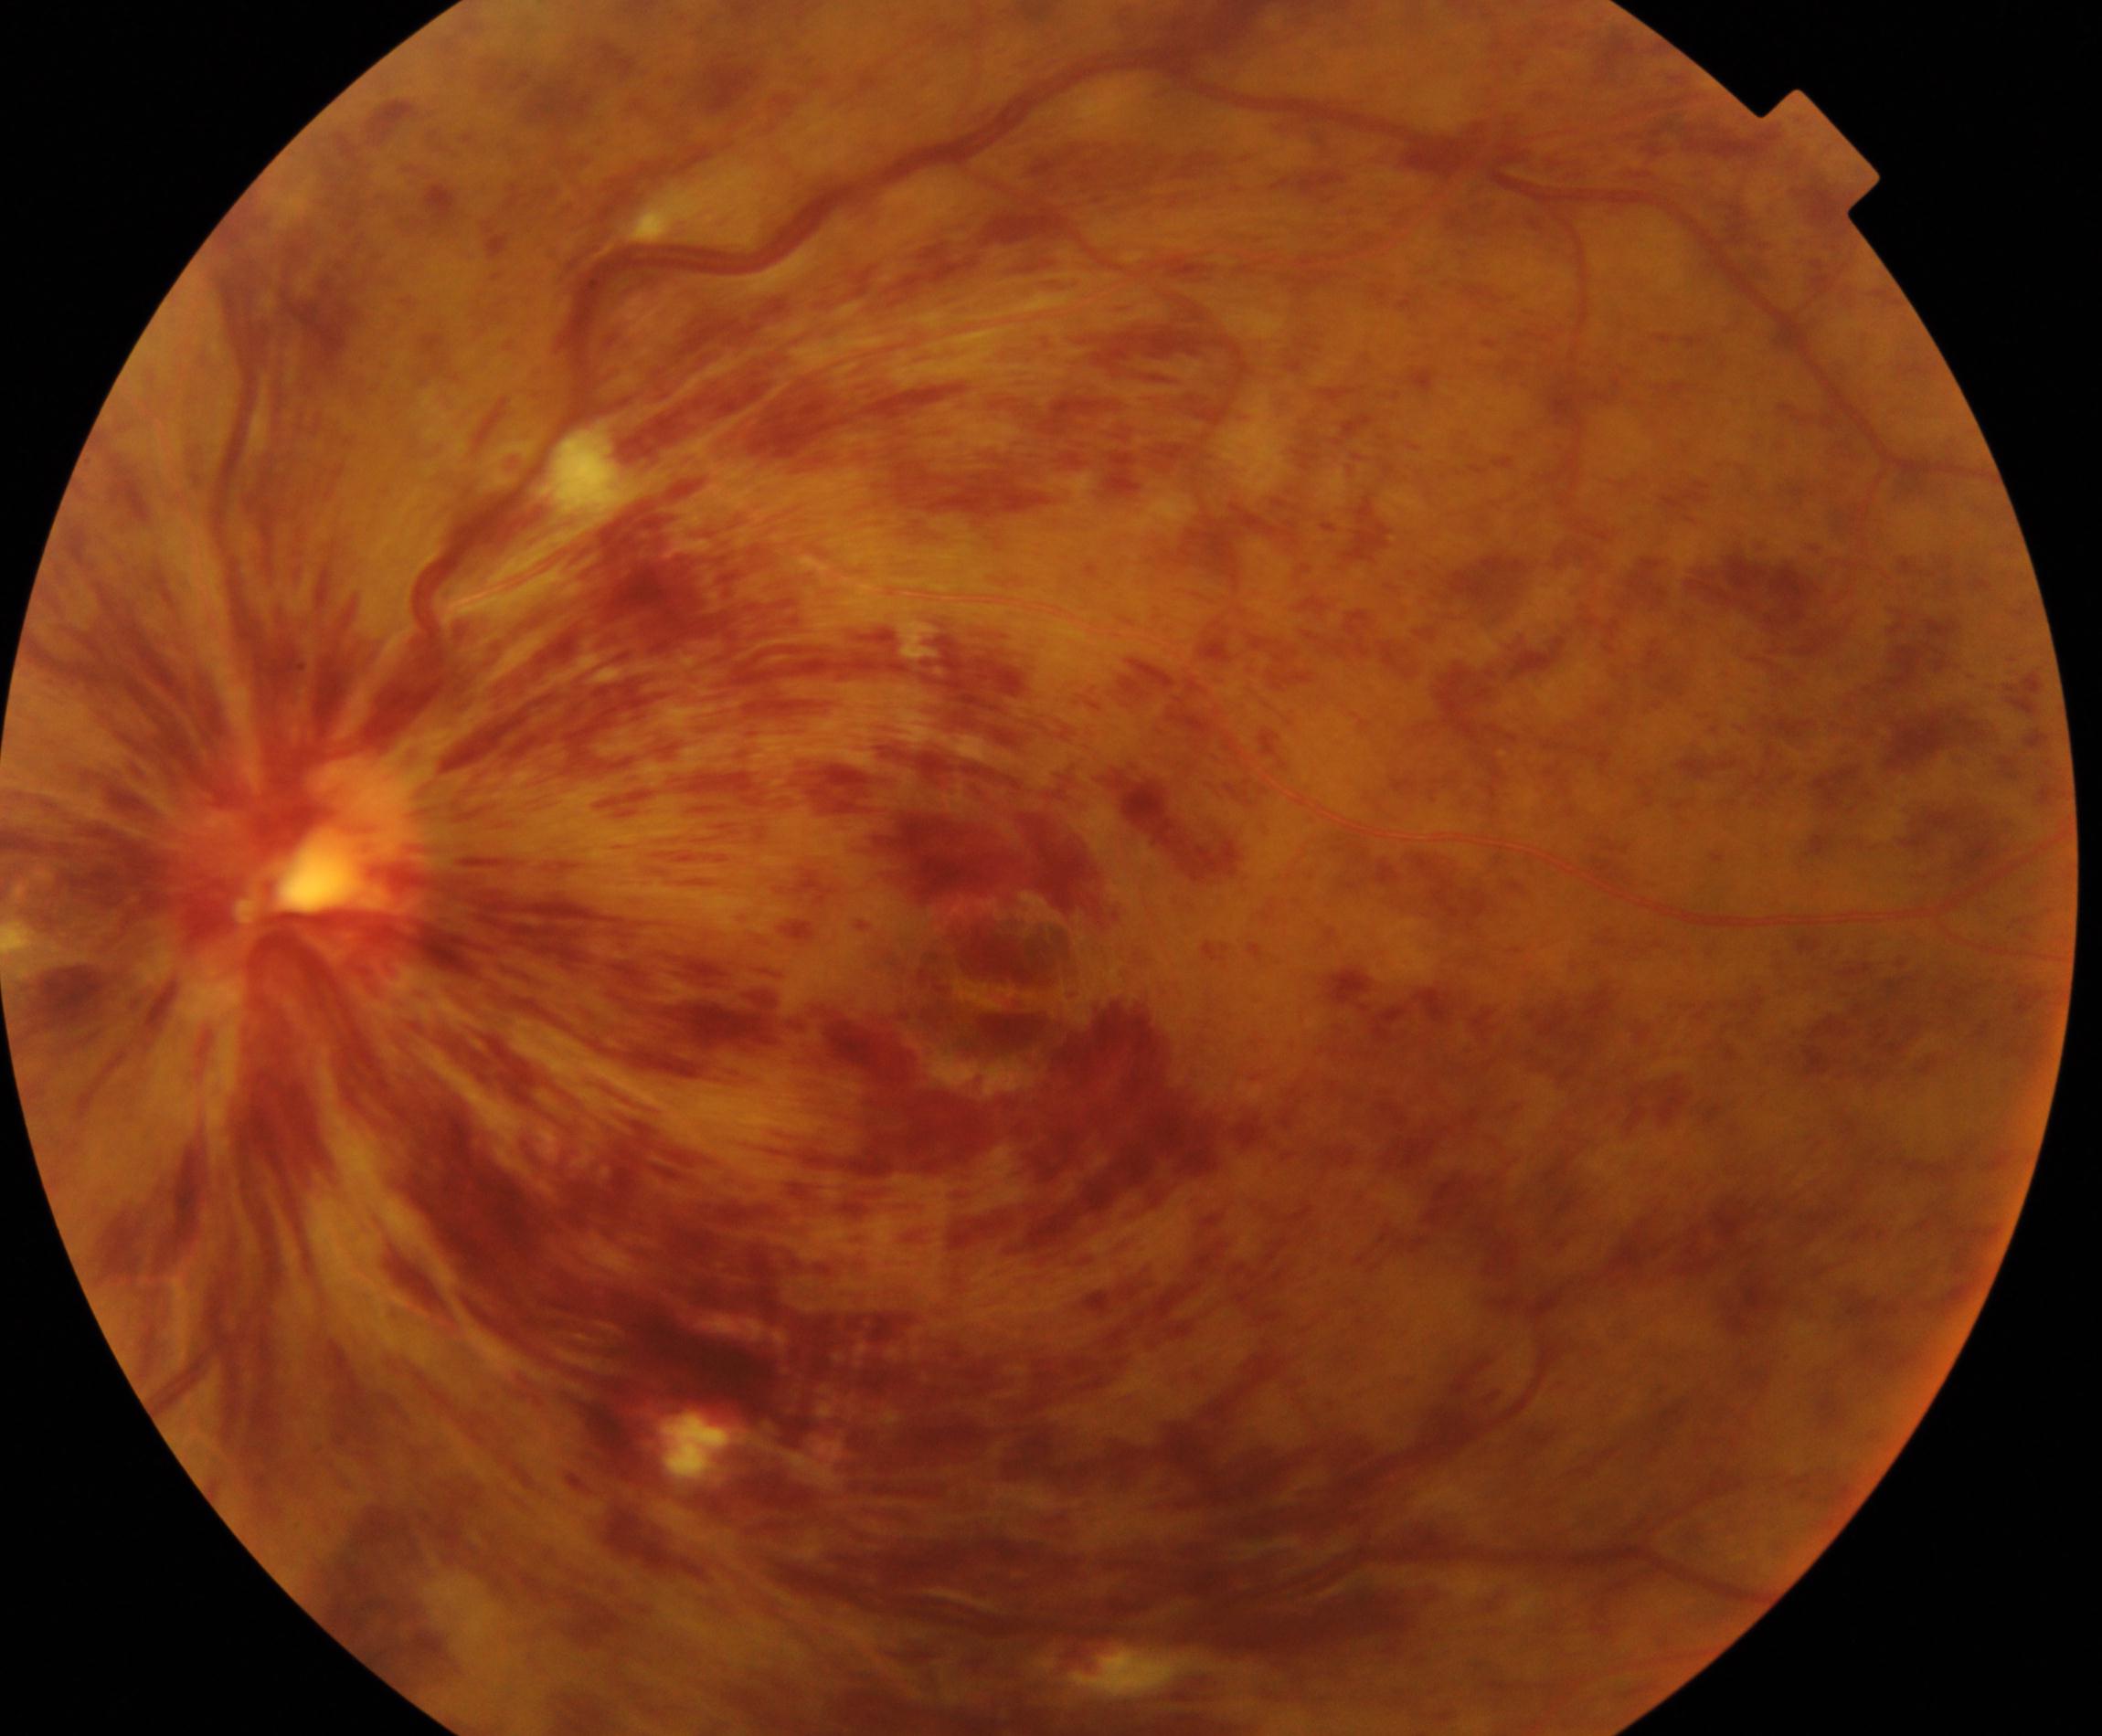
Appearance consistent with central retinal vein occlusion.